Wide-field fundus image from infant ROP screening: 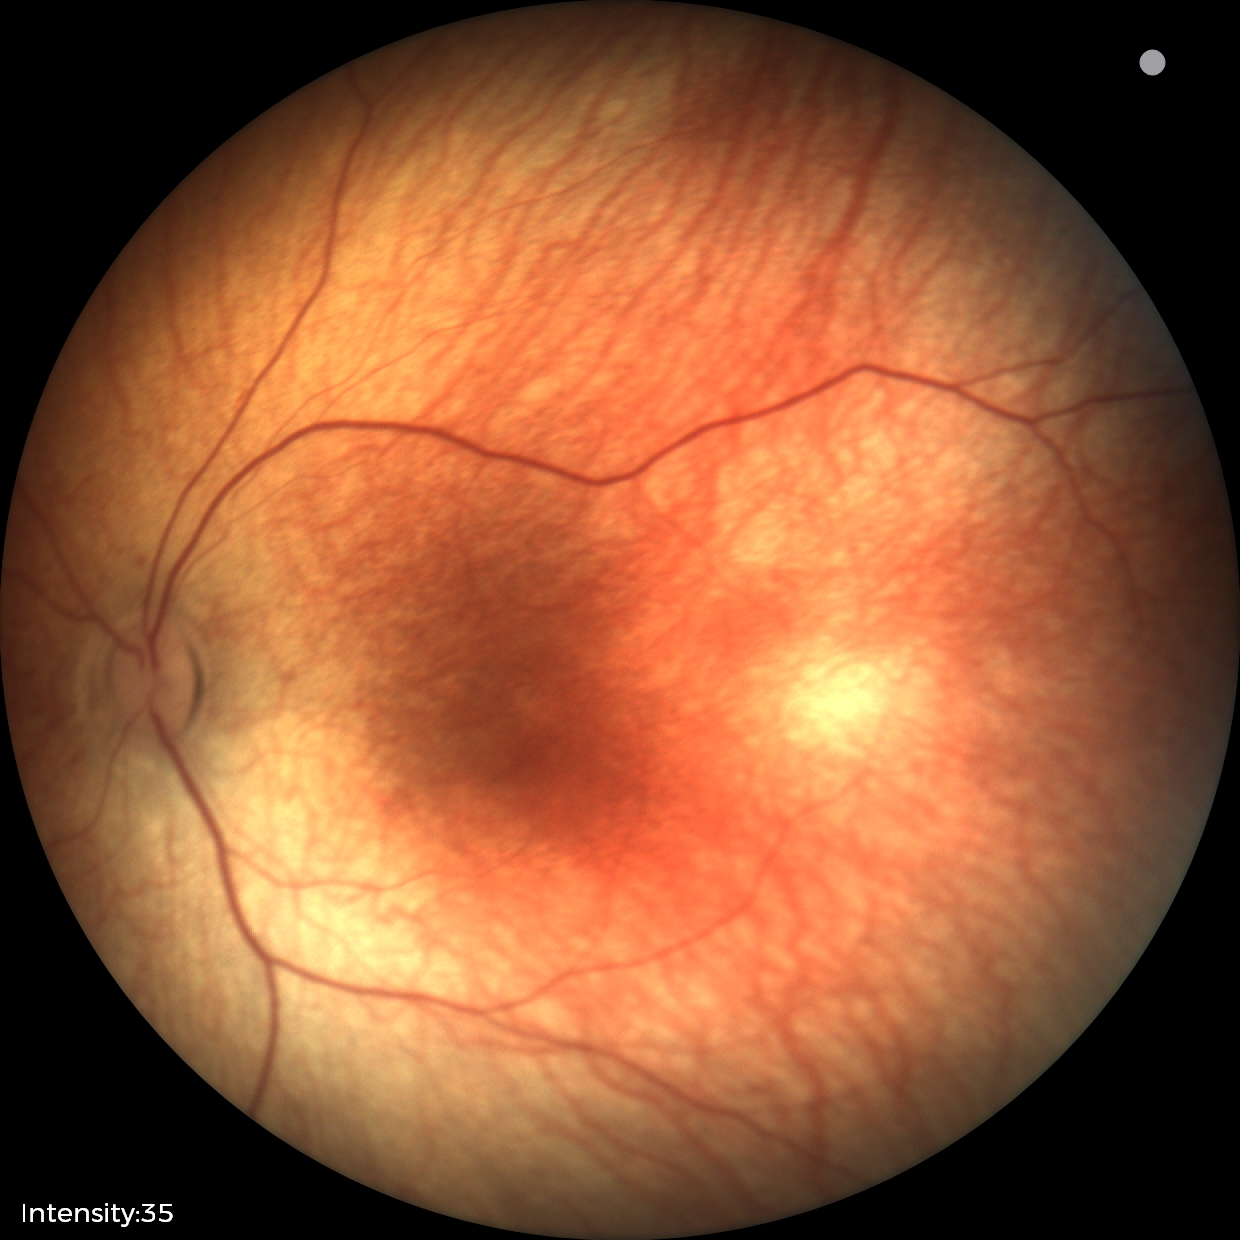 Screening examination diagnosed as physiological.